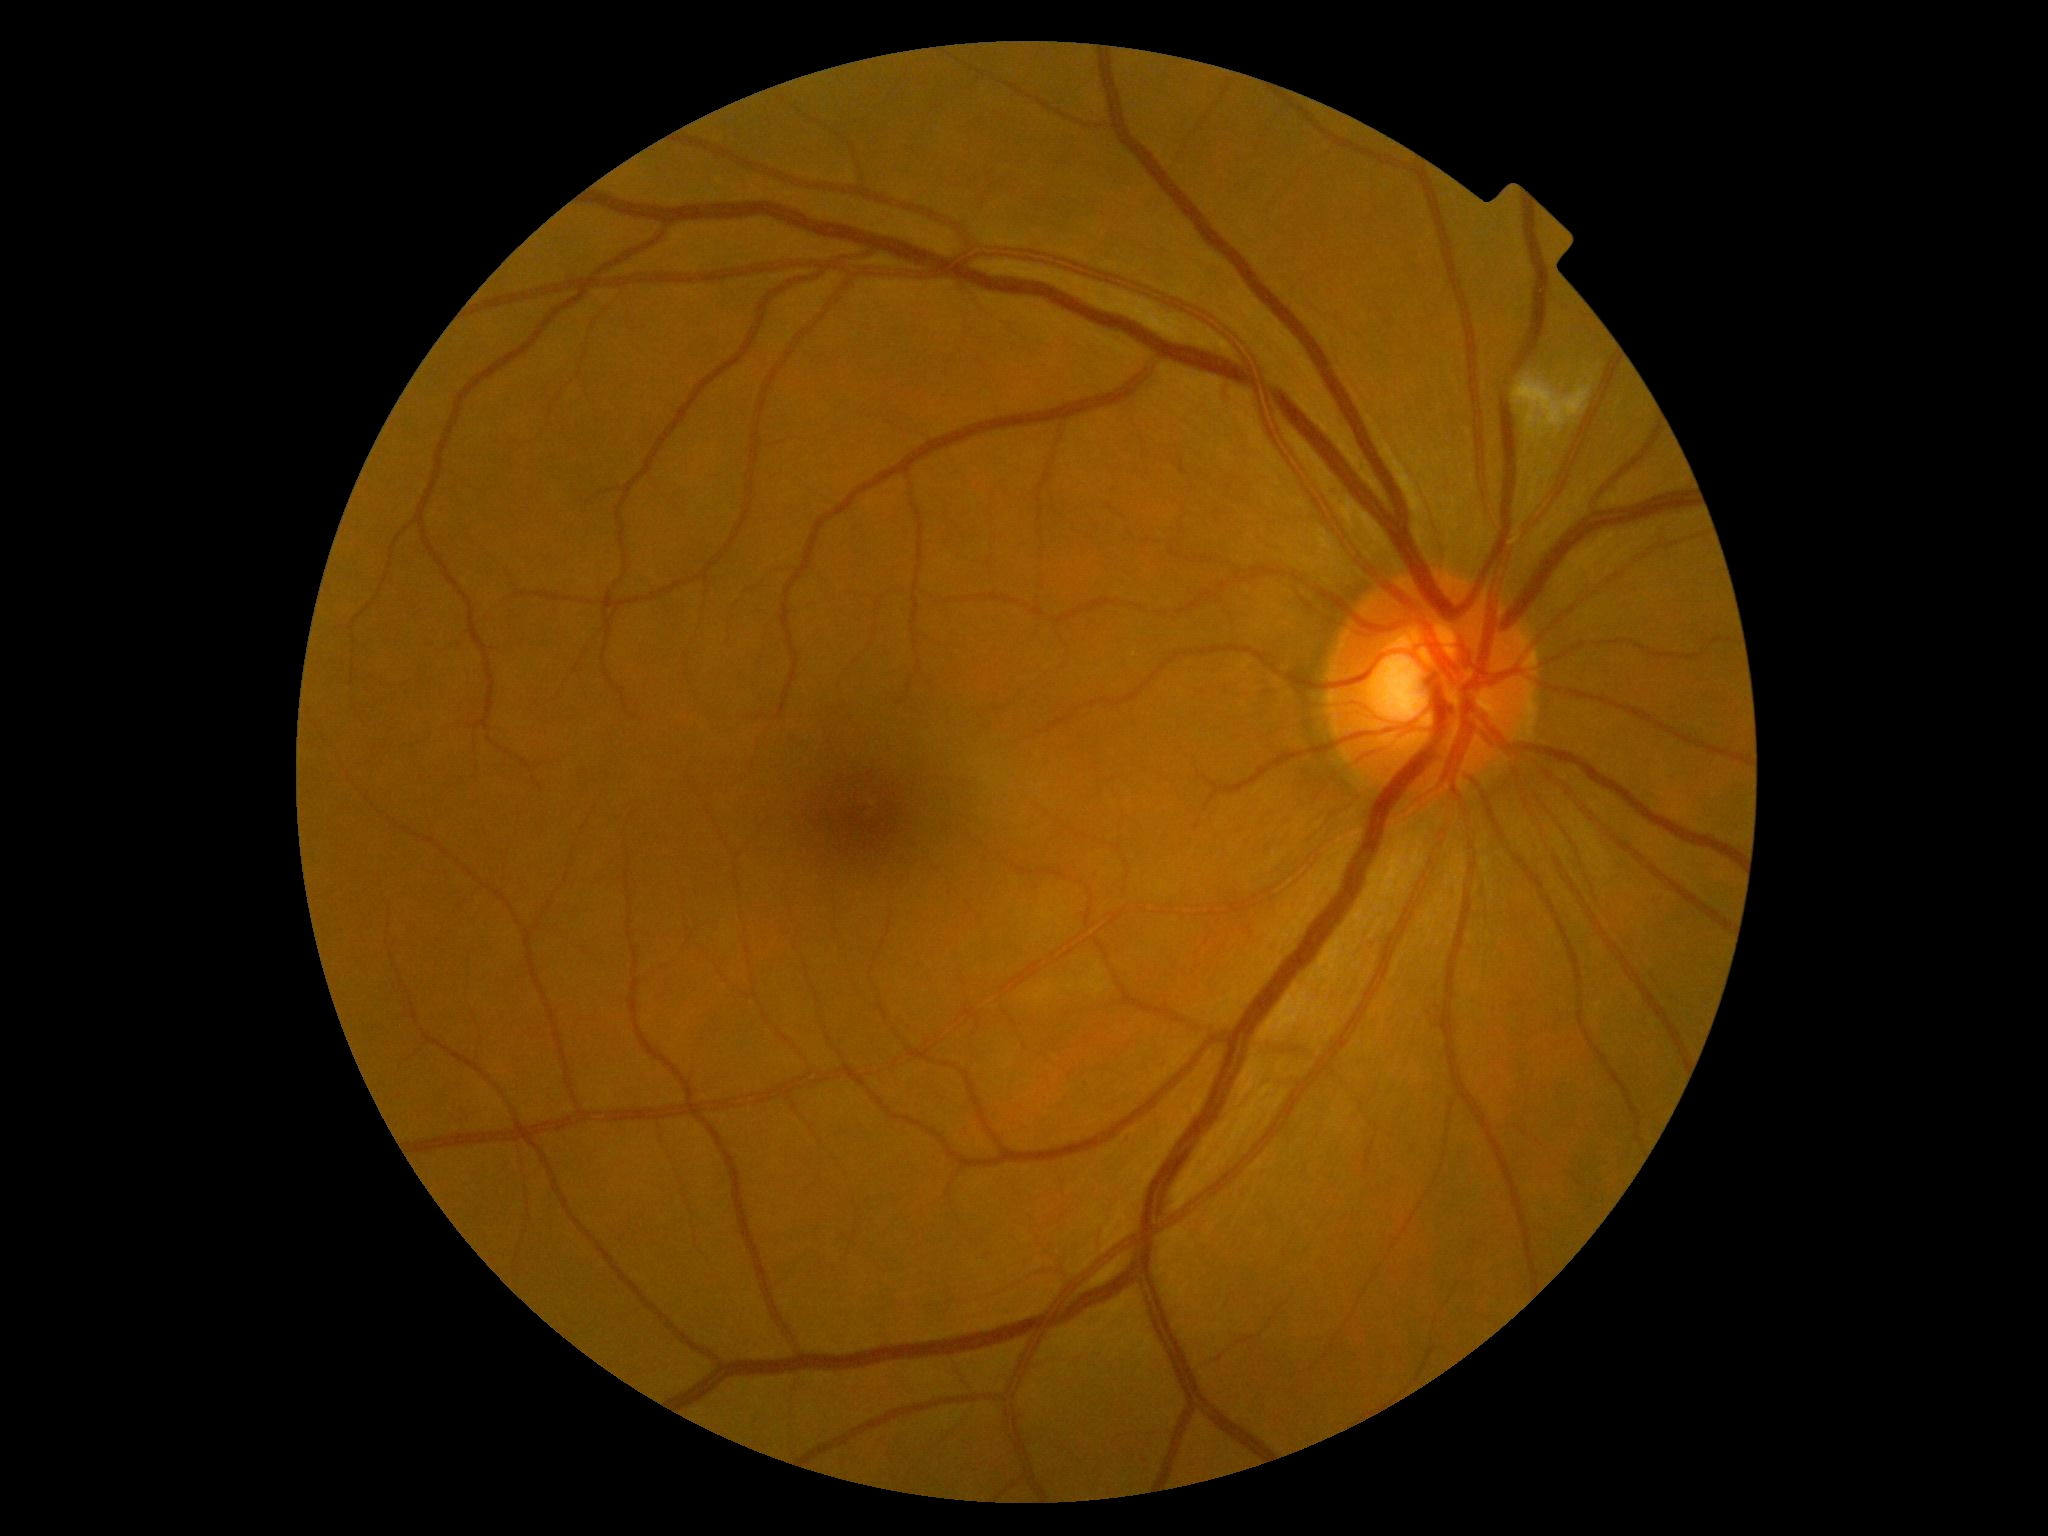
Retinopathy: 2 — more than just microaneurysms but less than severe NPDR.